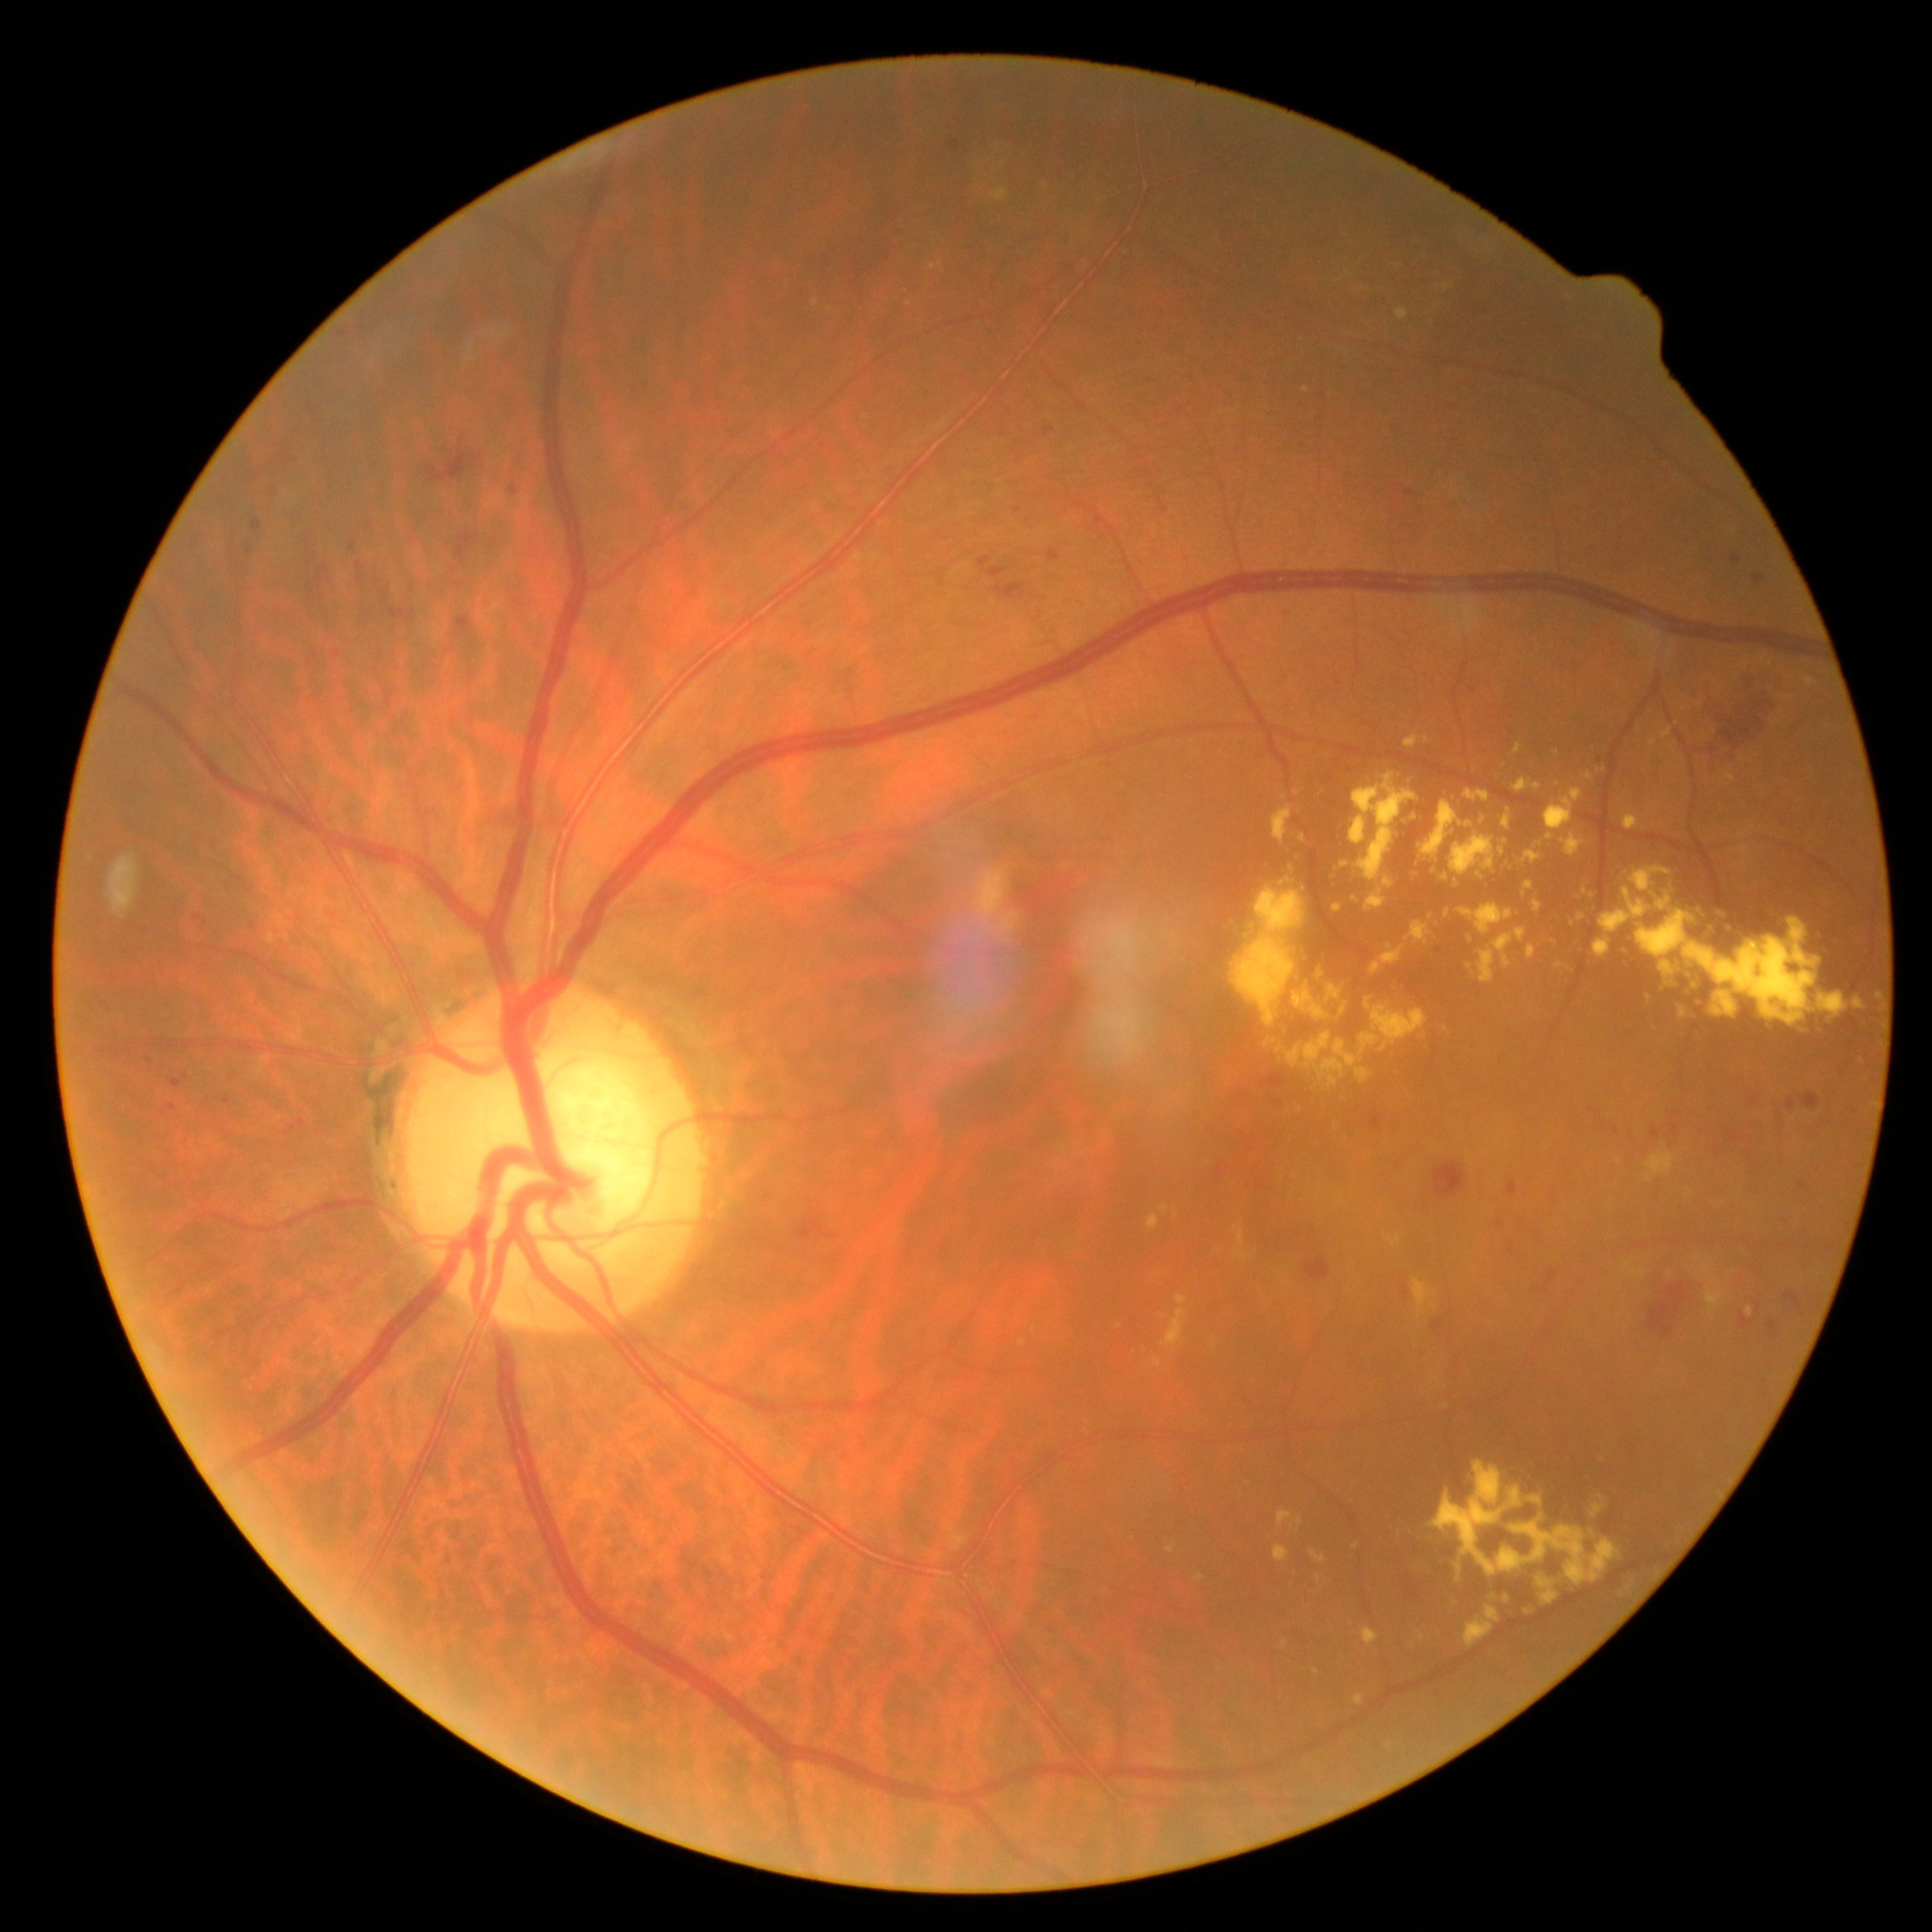

Diabetic retinopathy (DR): 2/4
A subset of detected lesions:
hemorrhages (HEs) (partial): l=252, t=518, r=262, b=532 | l=1020, t=517, r=1031, b=526 | l=1748, t=1097, r=1757, b=1105 | l=1256, t=1185, r=1264, b=1191 | l=529, t=497, r=542, b=512 | l=1368, t=1111, r=1382, b=1130 | l=1509, t=1245, r=1512, b=1253 | l=365, t=526, r=373, b=532 | l=349, t=542, r=356, b=553 | l=1665, t=1111, r=1683, b=1149 | l=1413, t=885, r=1427, b=893 | l=795, t=1208, r=840, b=1245 | l=987, t=567, r=1014, b=580 | l=1432, t=1319, r=1444, b=1332
Smaller HEs around (1259, 1164) | (1252, 1148) | (380, 580)